1380 x 1382 pixels. 45° field of view. Retinal fundus photograph: 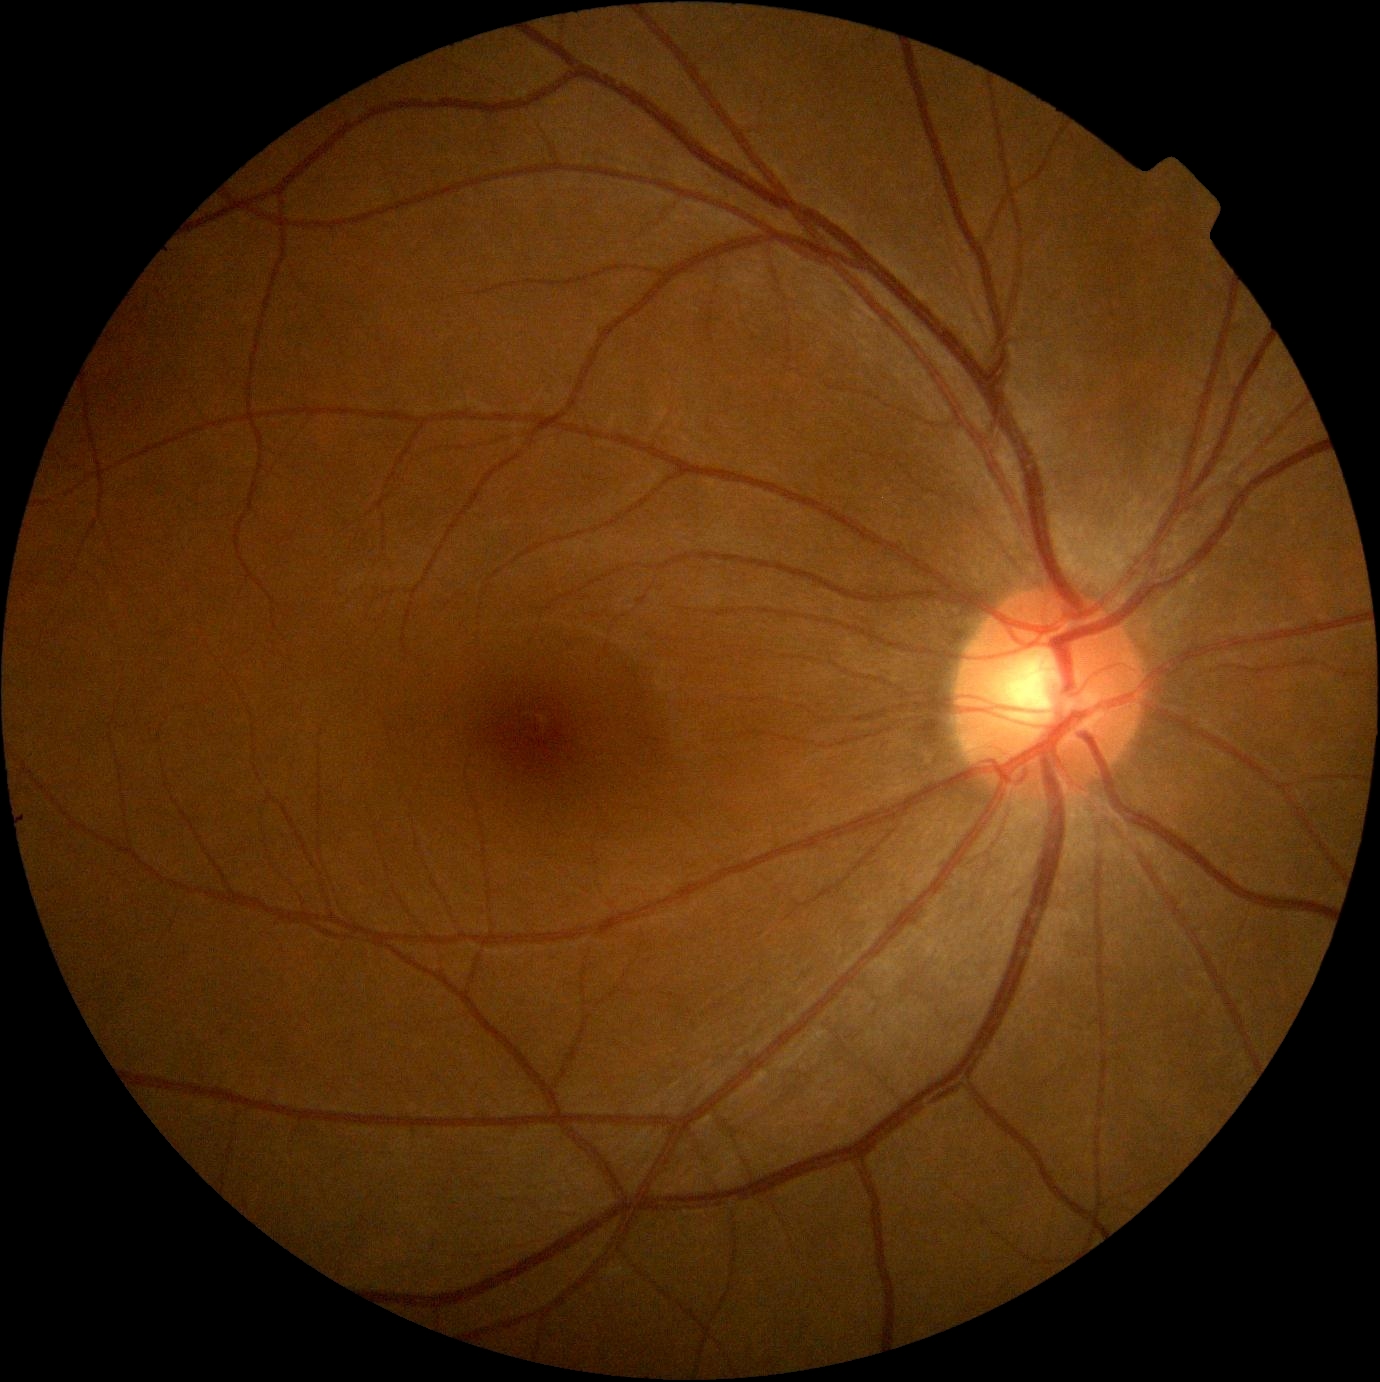 DR impression: negative for DR | DR grade: 0.